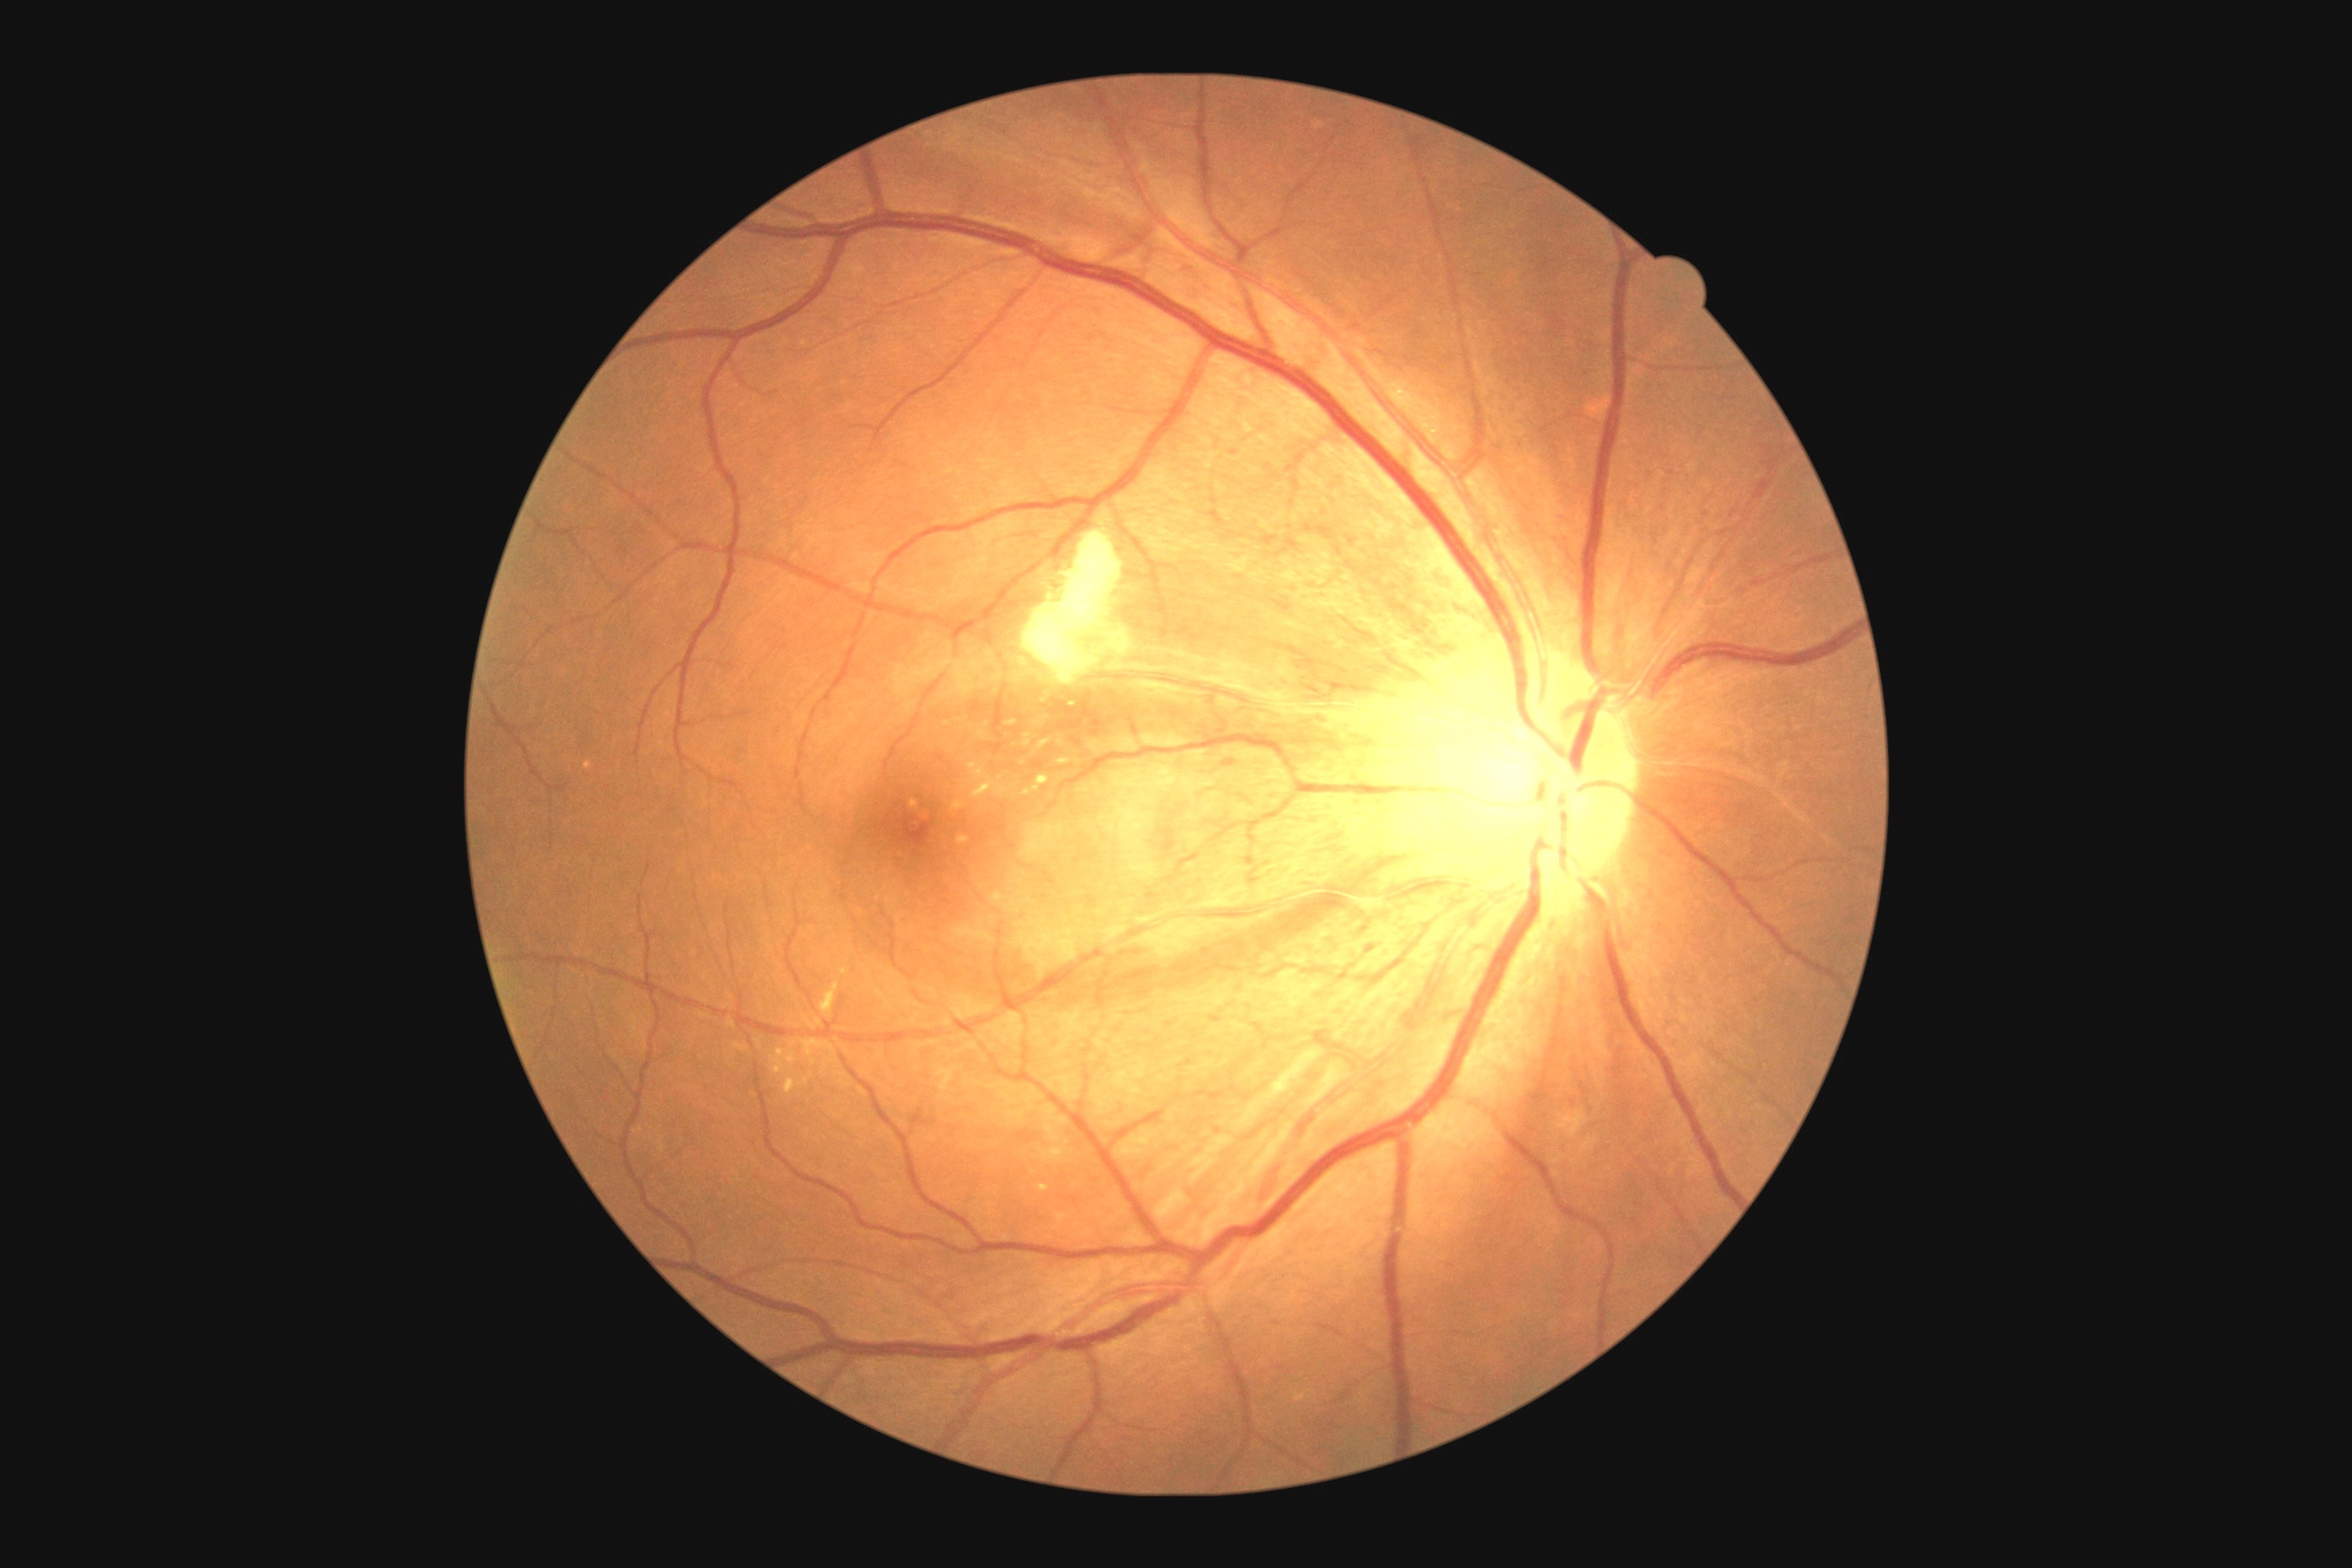

Retinopathy: moderate NPDR (grade 2).